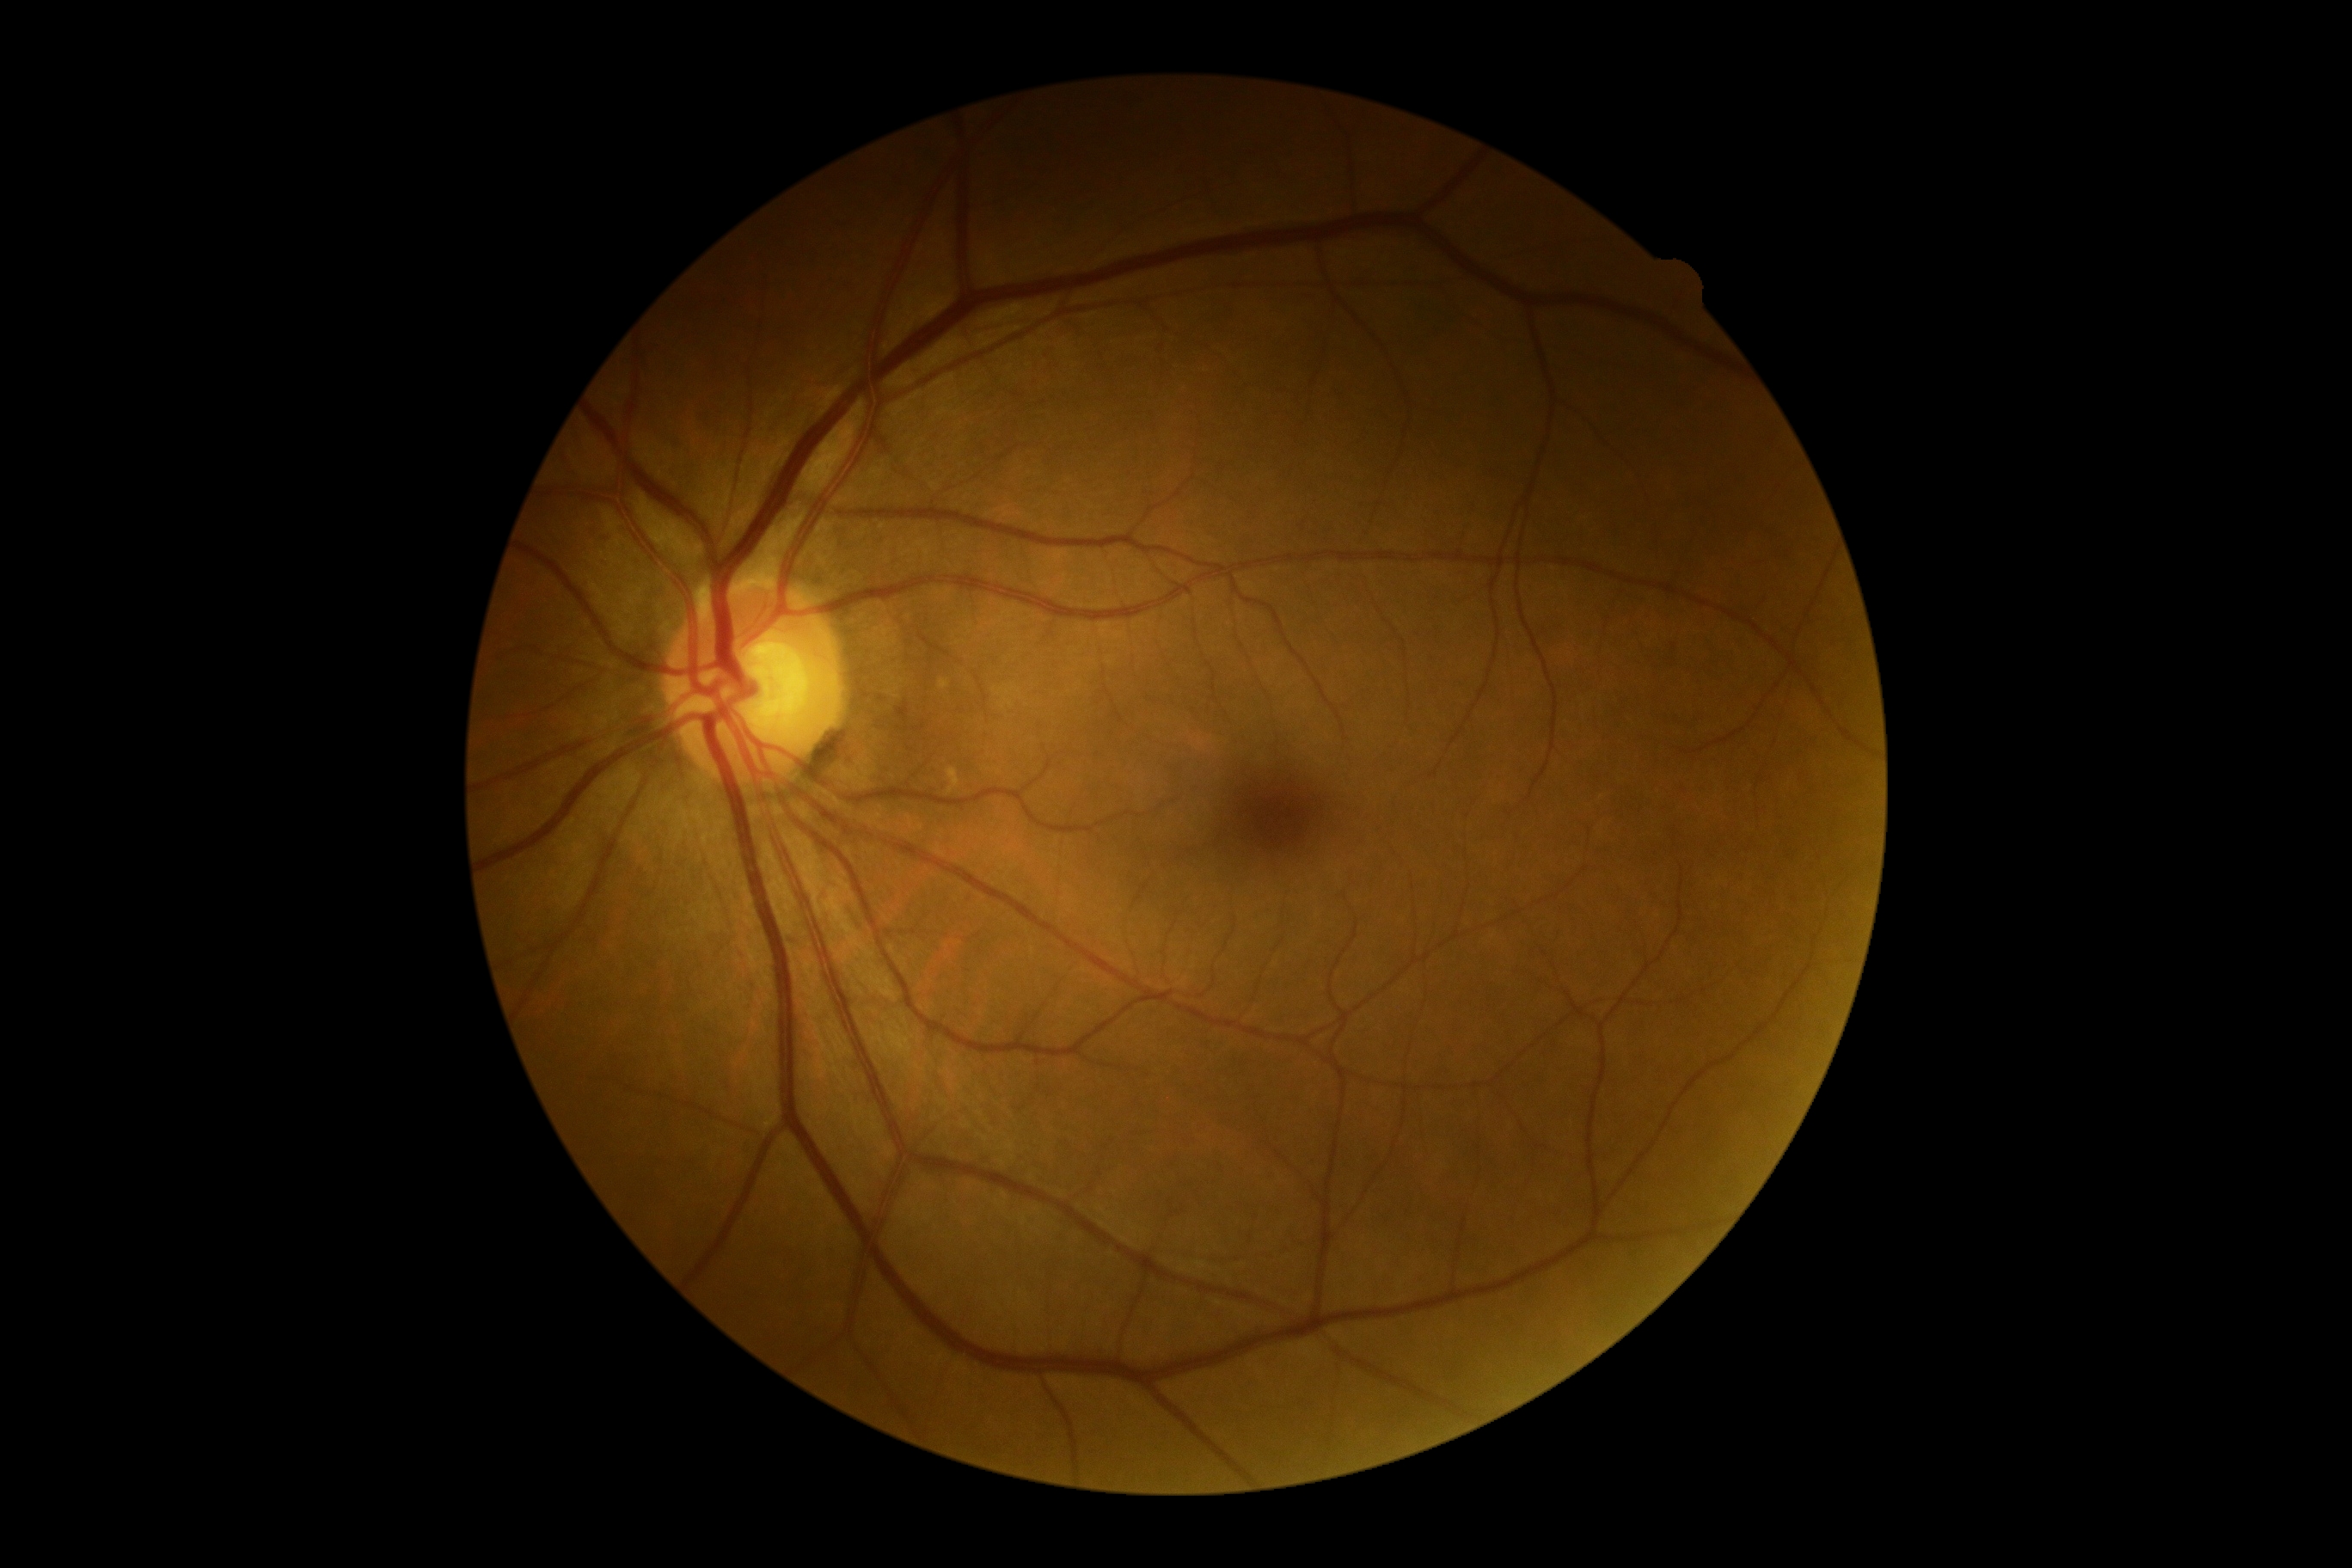
dr_grade: no apparent diabetic retinopathy (grade 0)